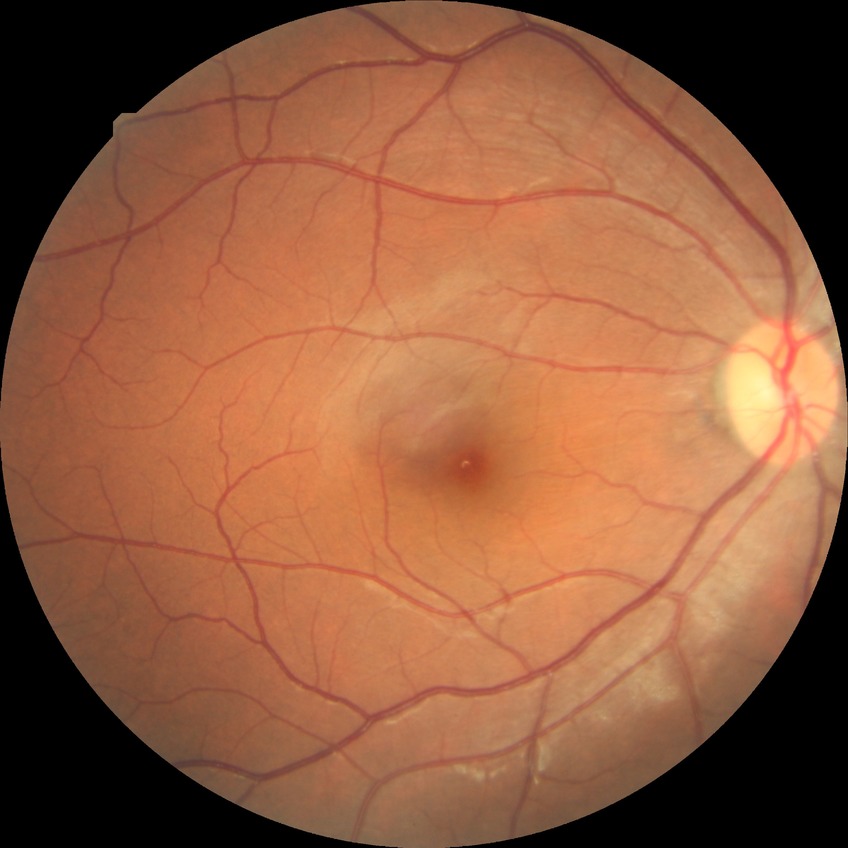

Diabetic retinopathy (DR) is no diabetic retinopathy (NDR).